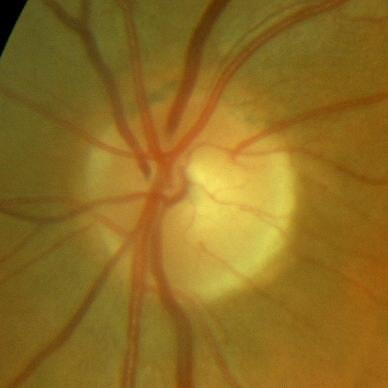
Glaucoma diagnosis = no glaucomatous findings.